Infant wide-field fundus photograph:
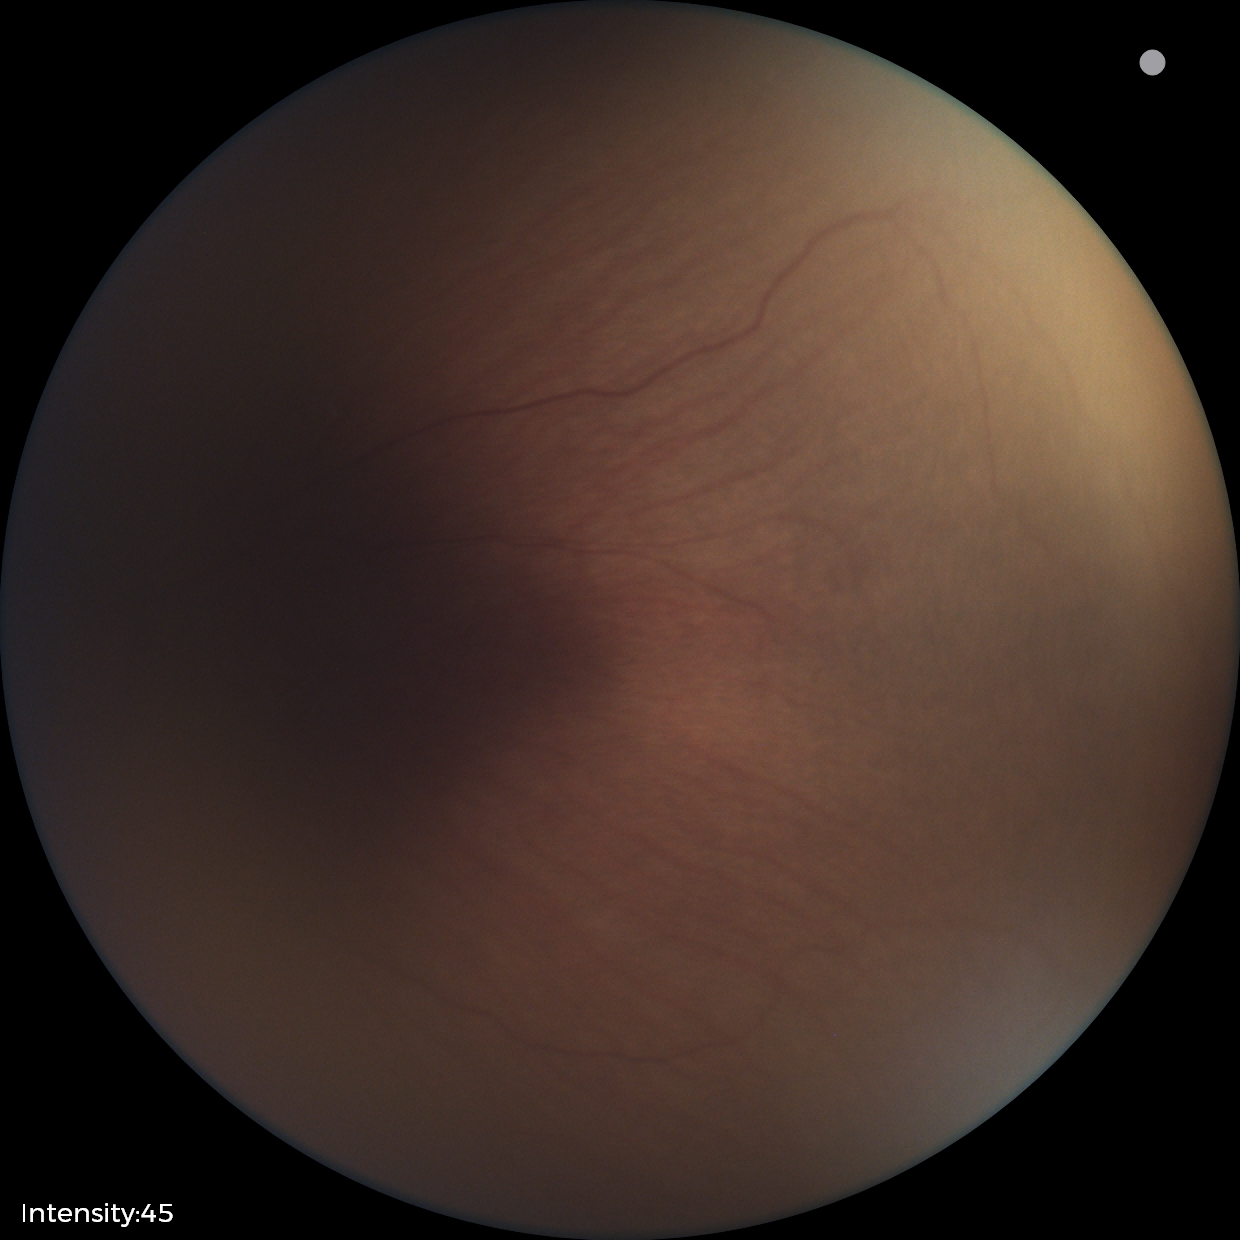

Q: What was the screening finding?
A: status post retinopathy of prematurity